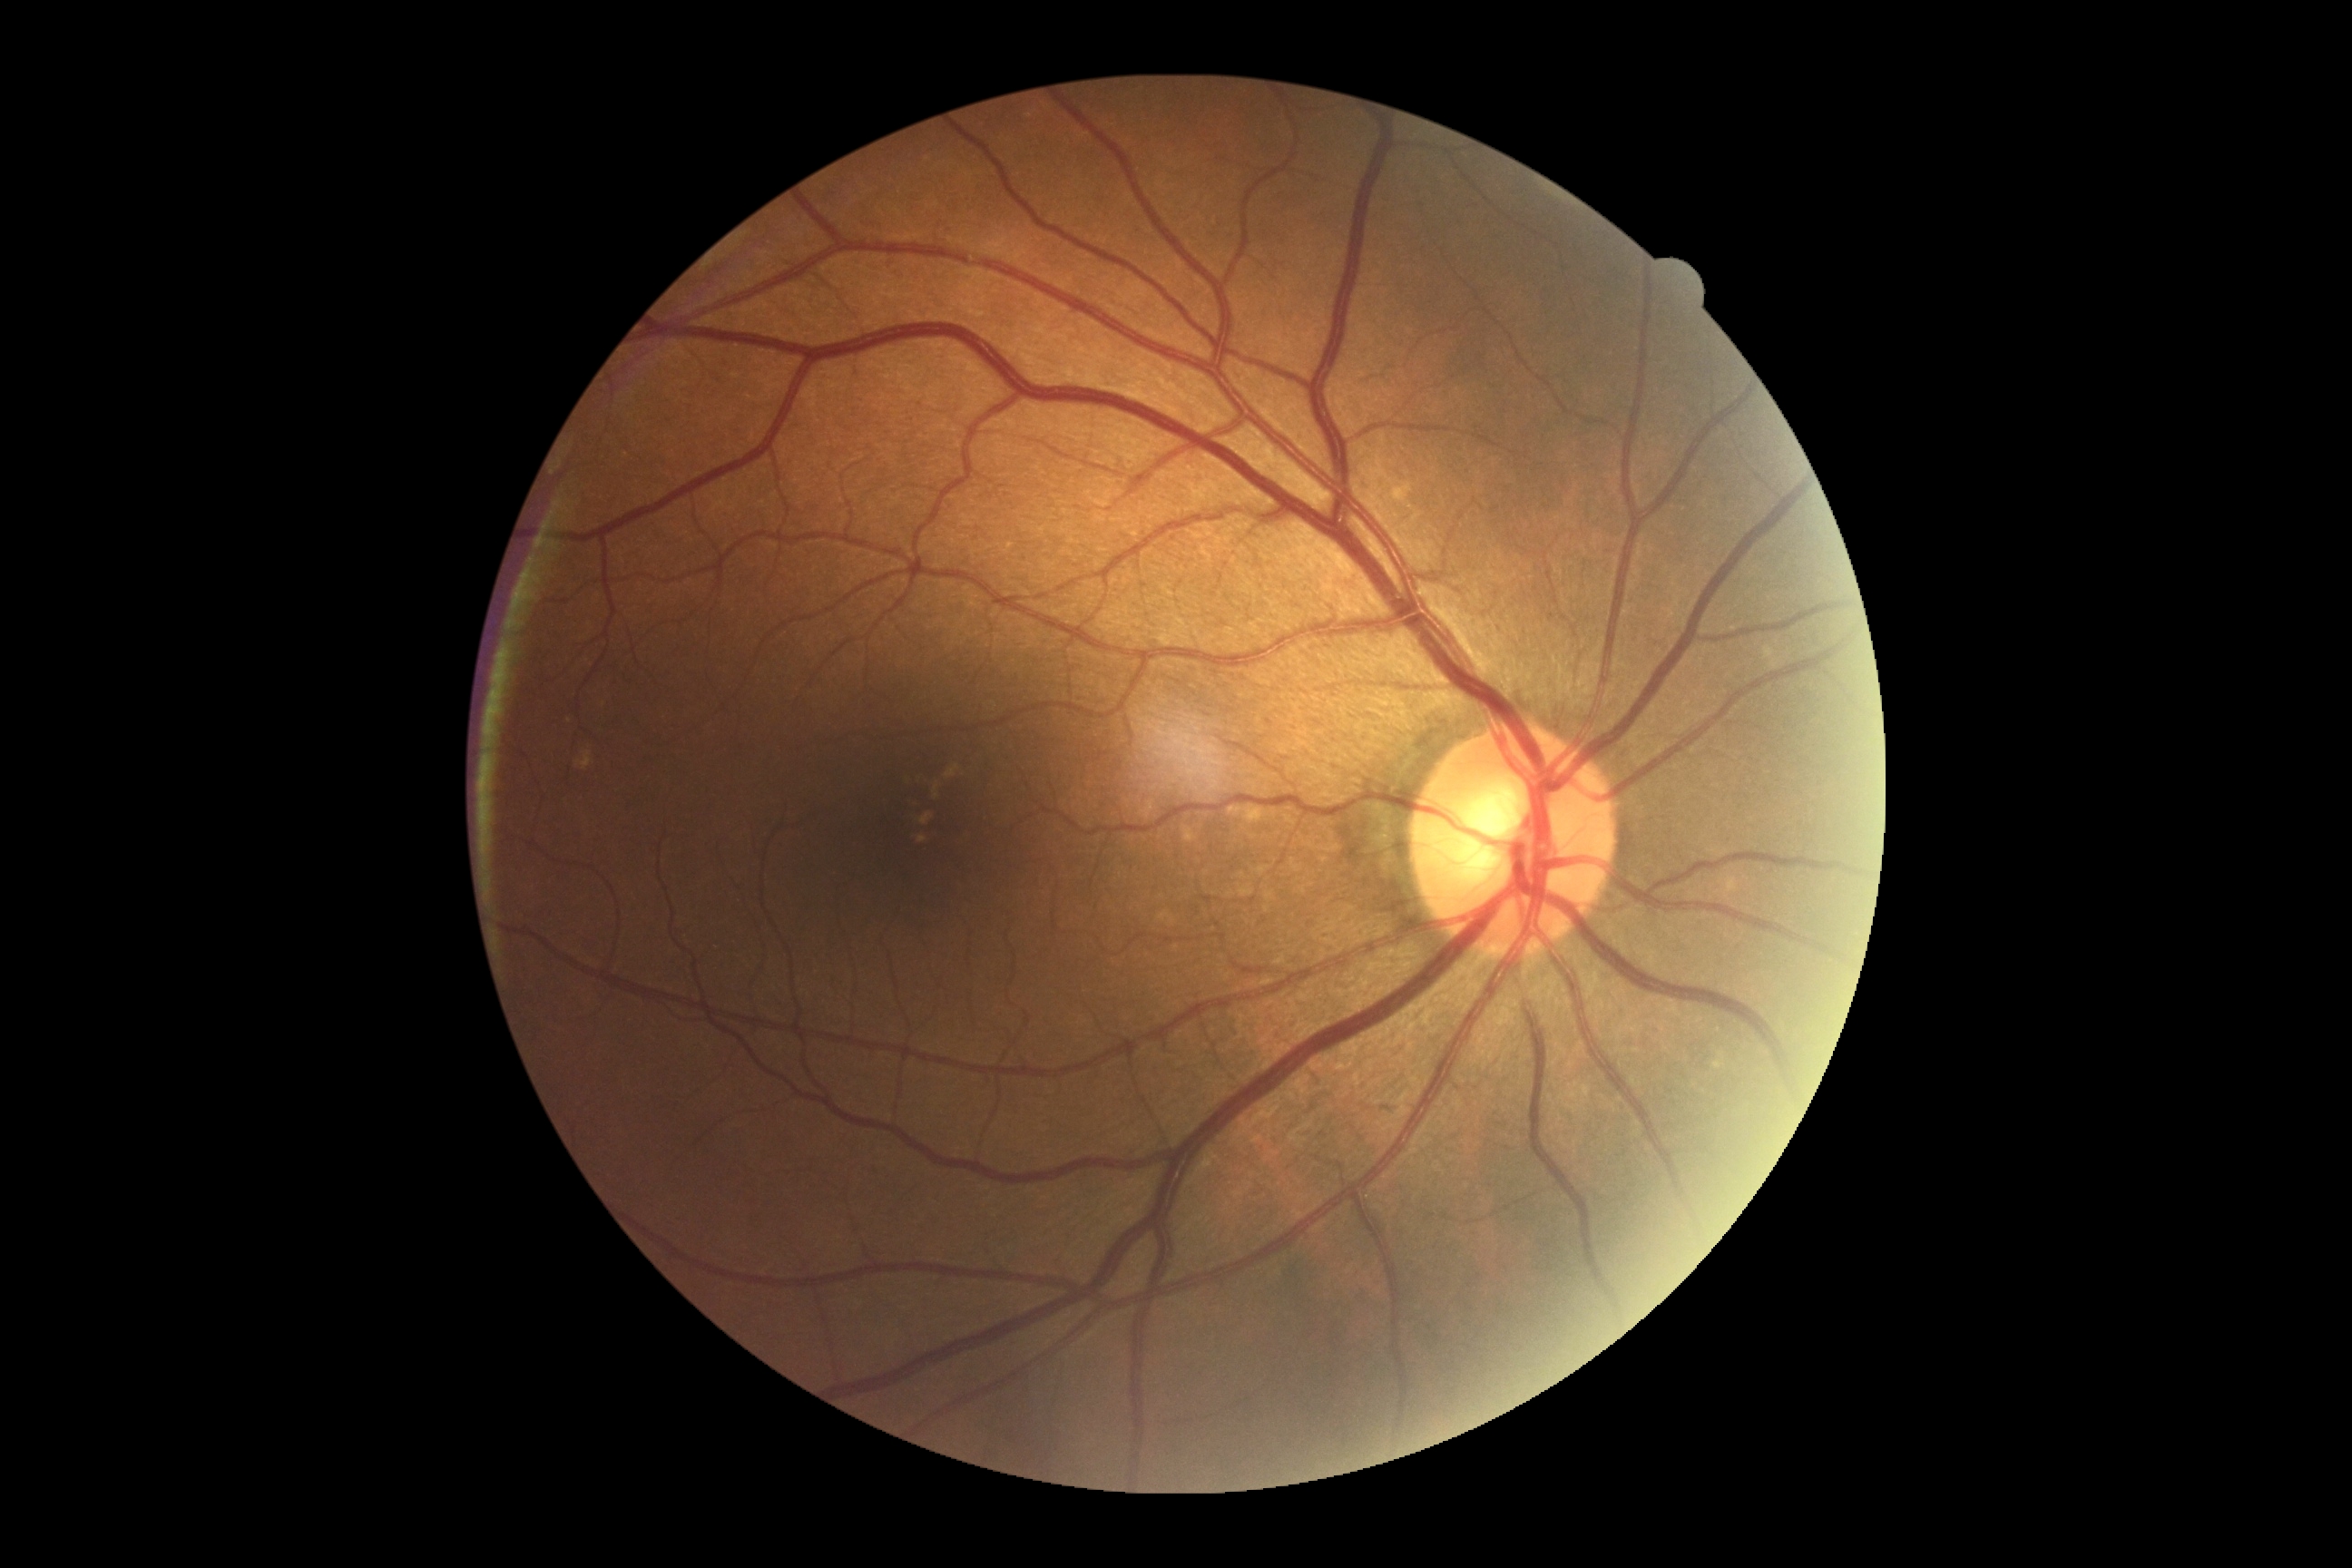 Annotations:
* DR impression: no apparent DR
* diabetic retinopathy grade: 0/4